Infant wide-field fundus photograph — 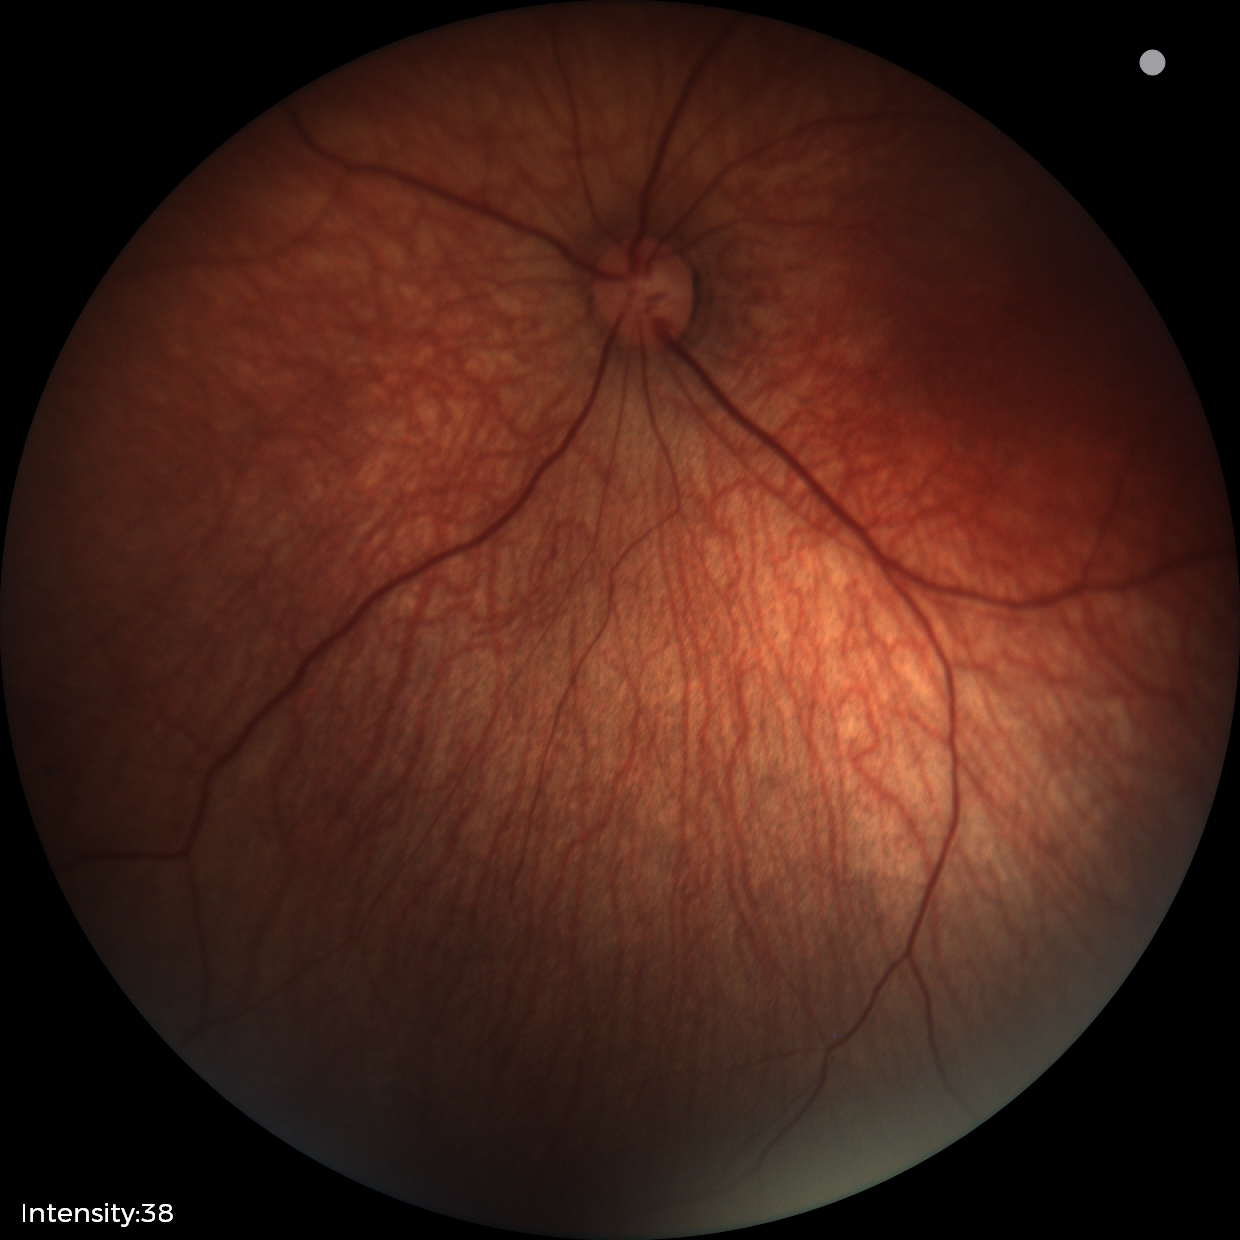 Screening examination with no abnormal retinal findings.